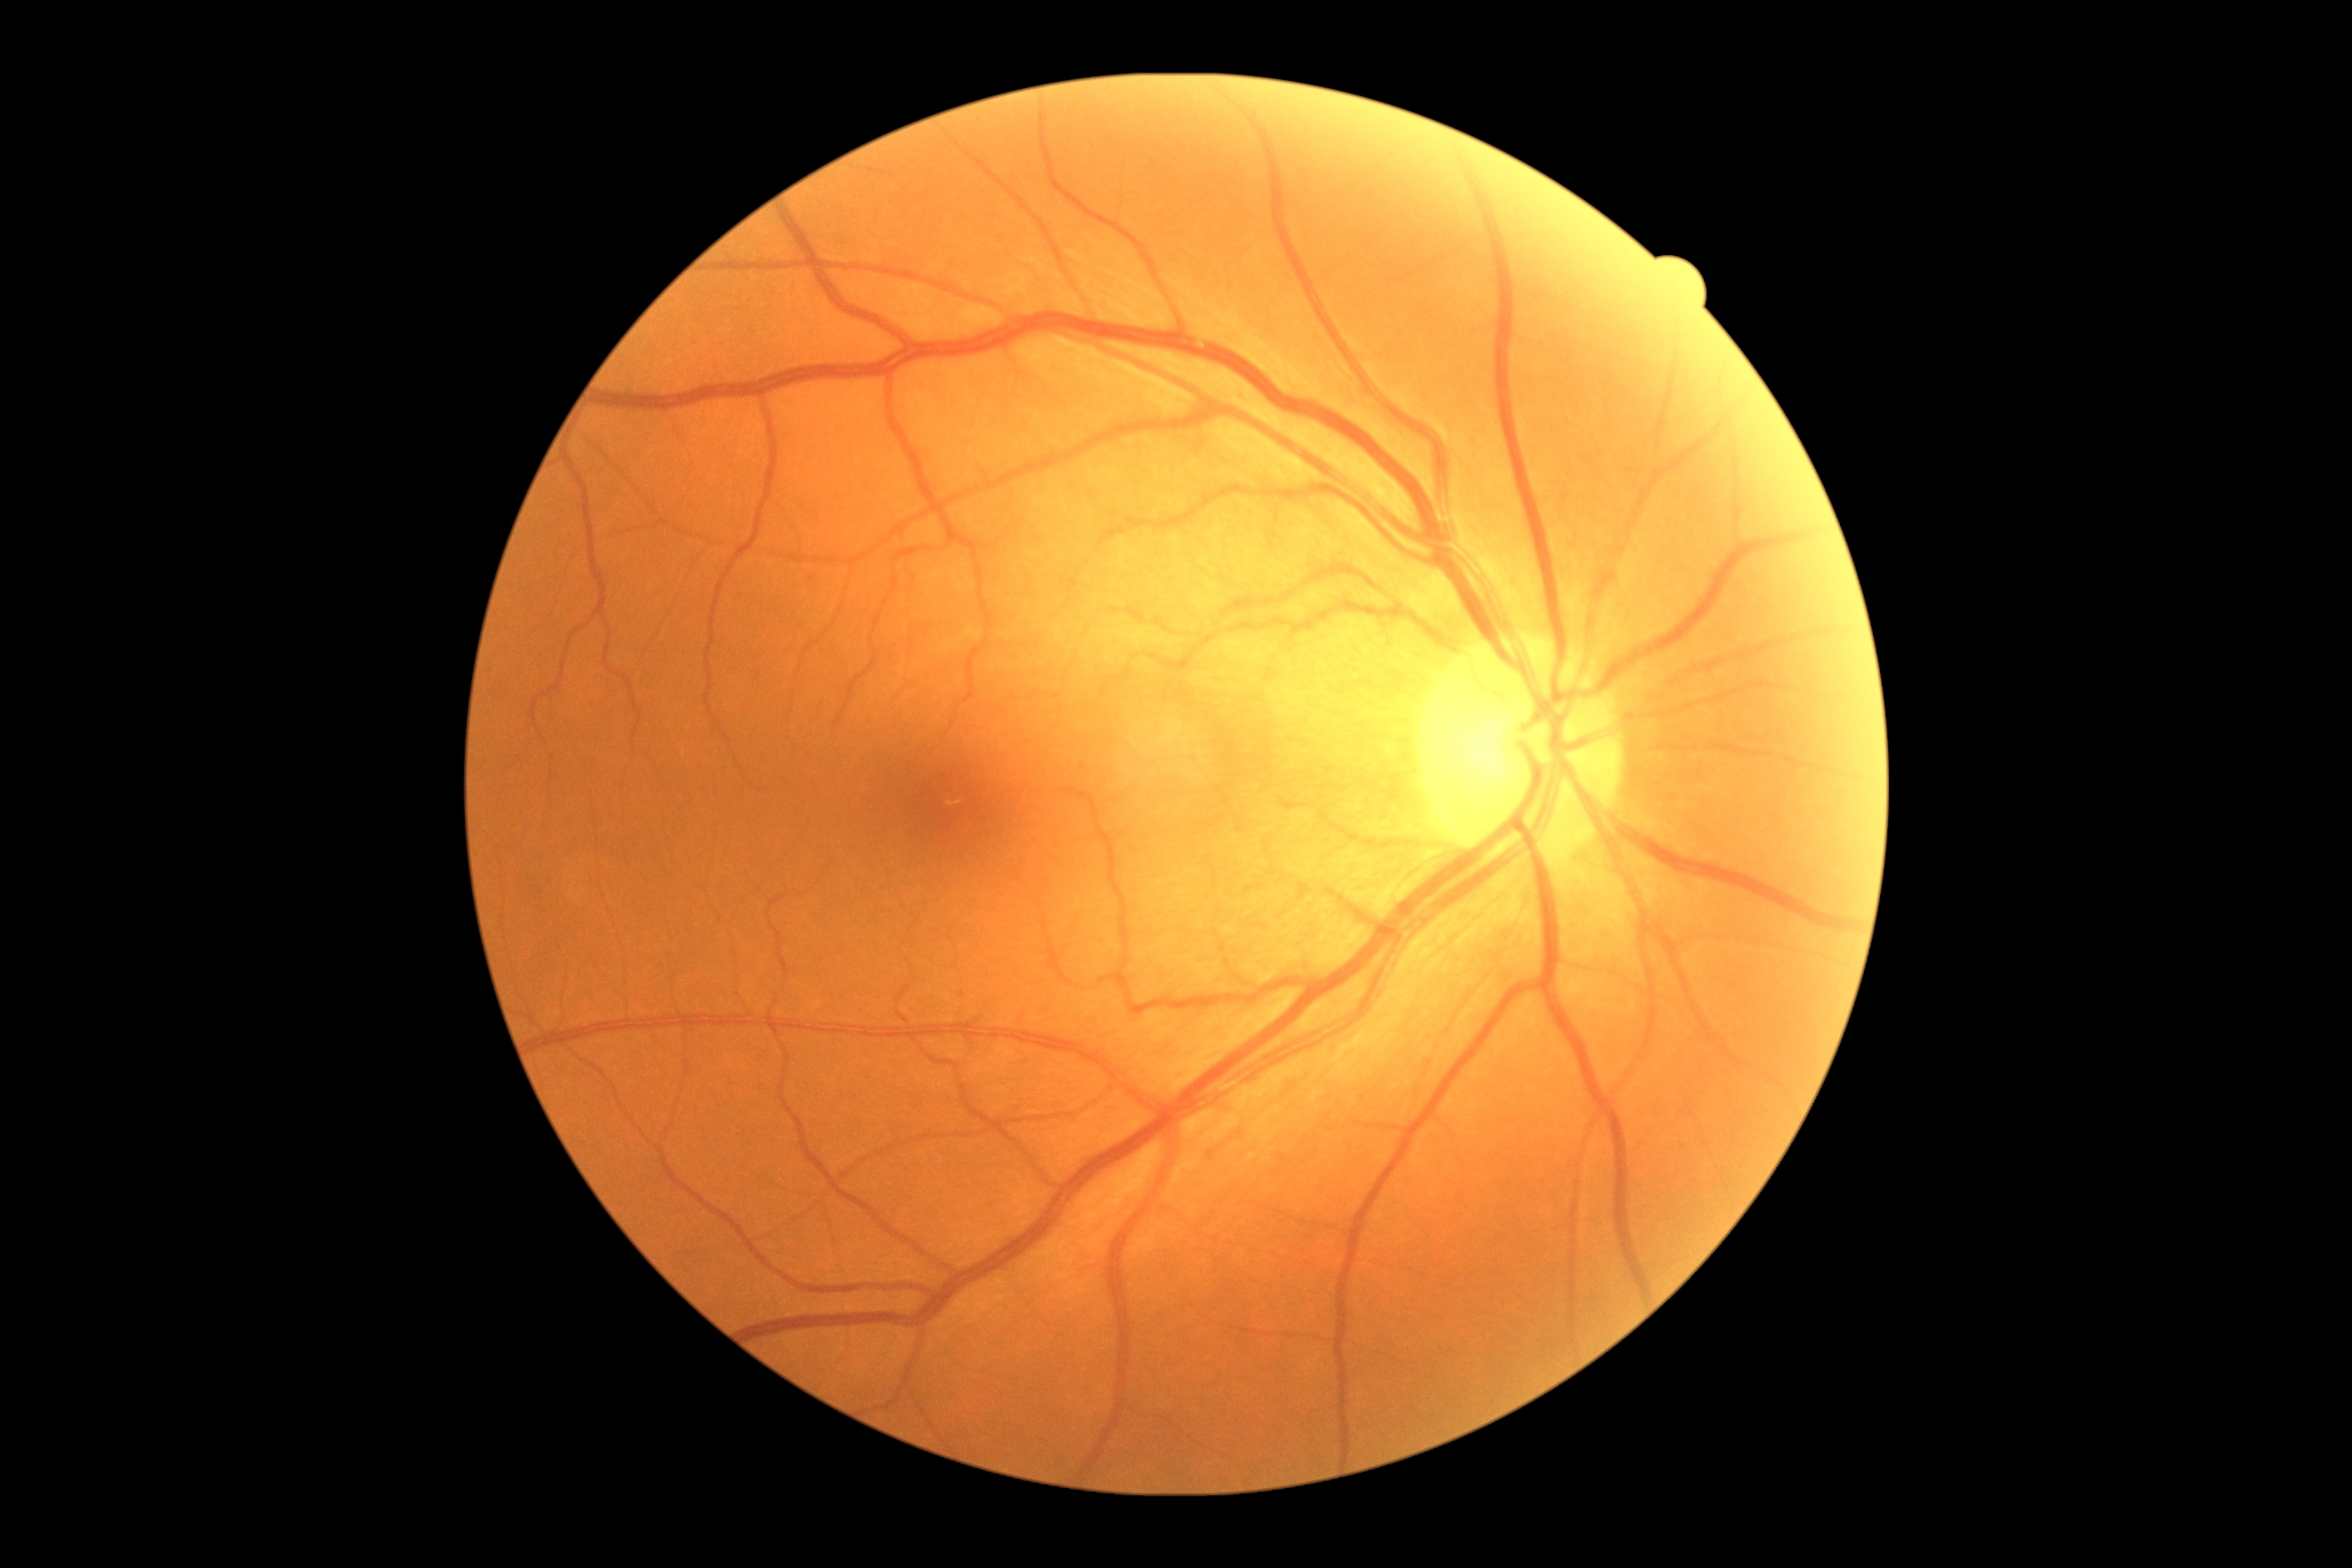 DR is grade 0 (no apparent retinopathy).
No diabetic retinal disease findings.